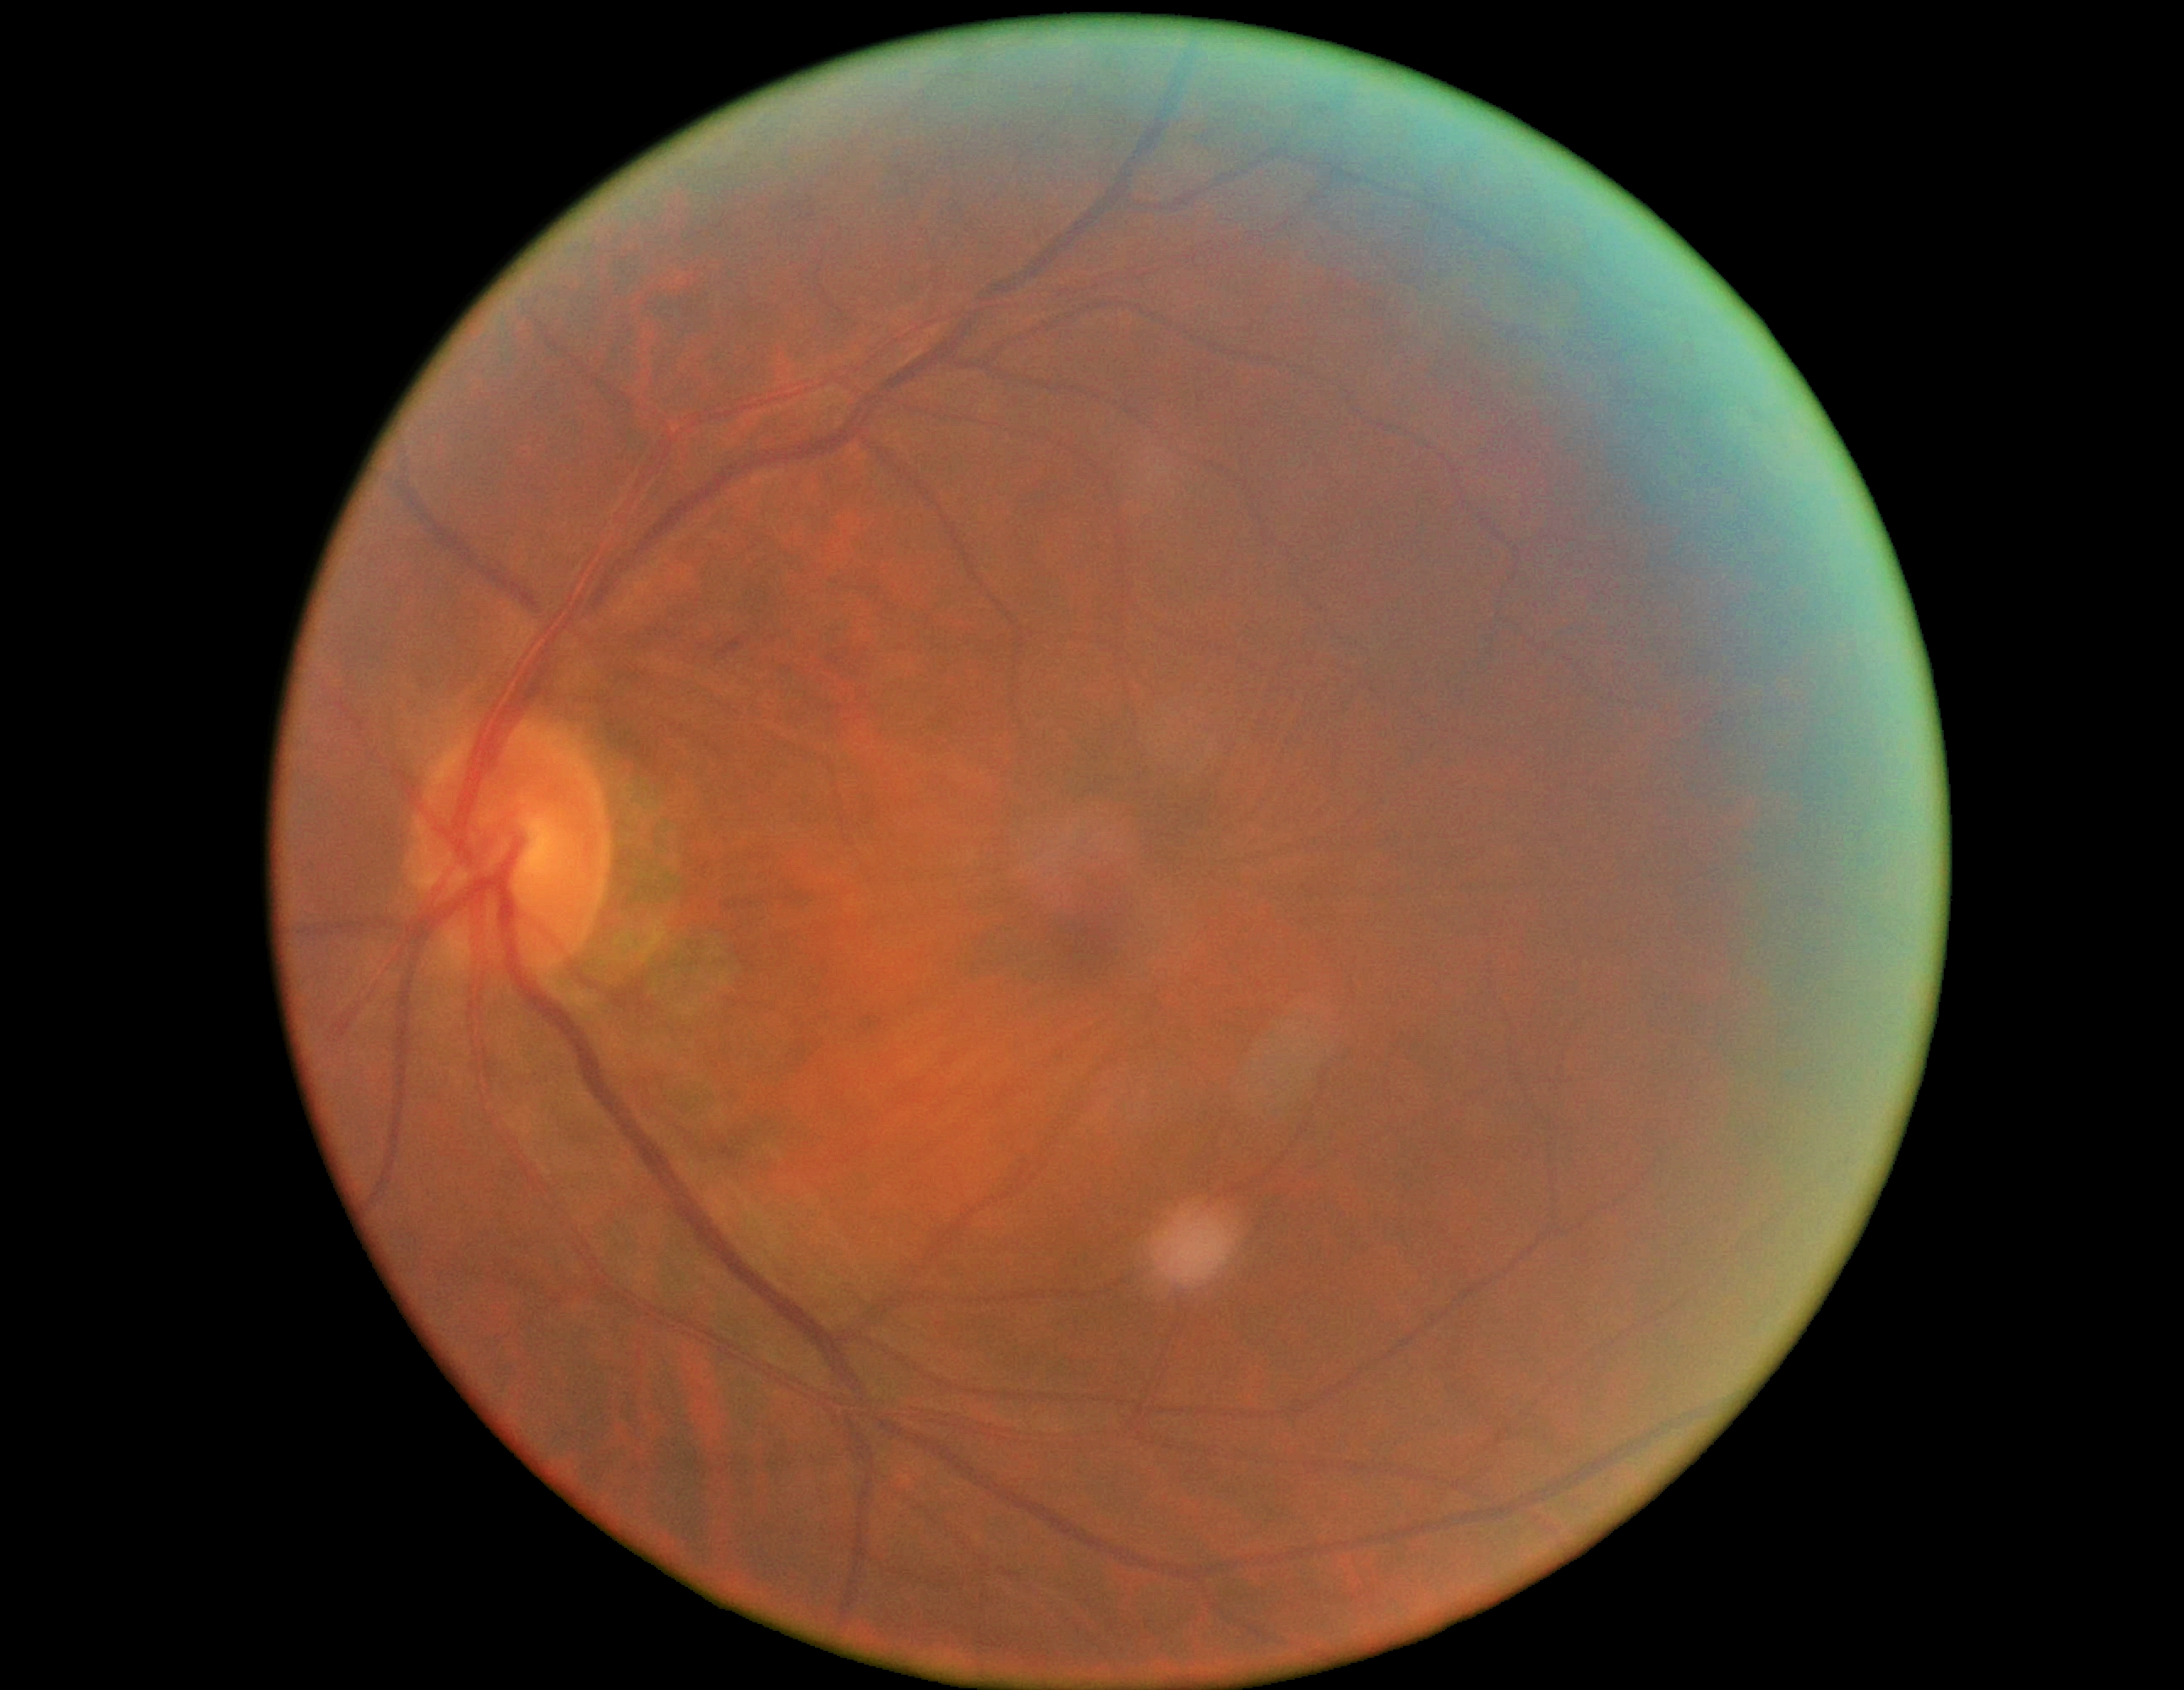
Diabetic retinopathy (DR) is grade 2.
The retinopathy is classified as non-proliferative diabetic retinopathy.